Captured on a Remidio Fundus on Phone — 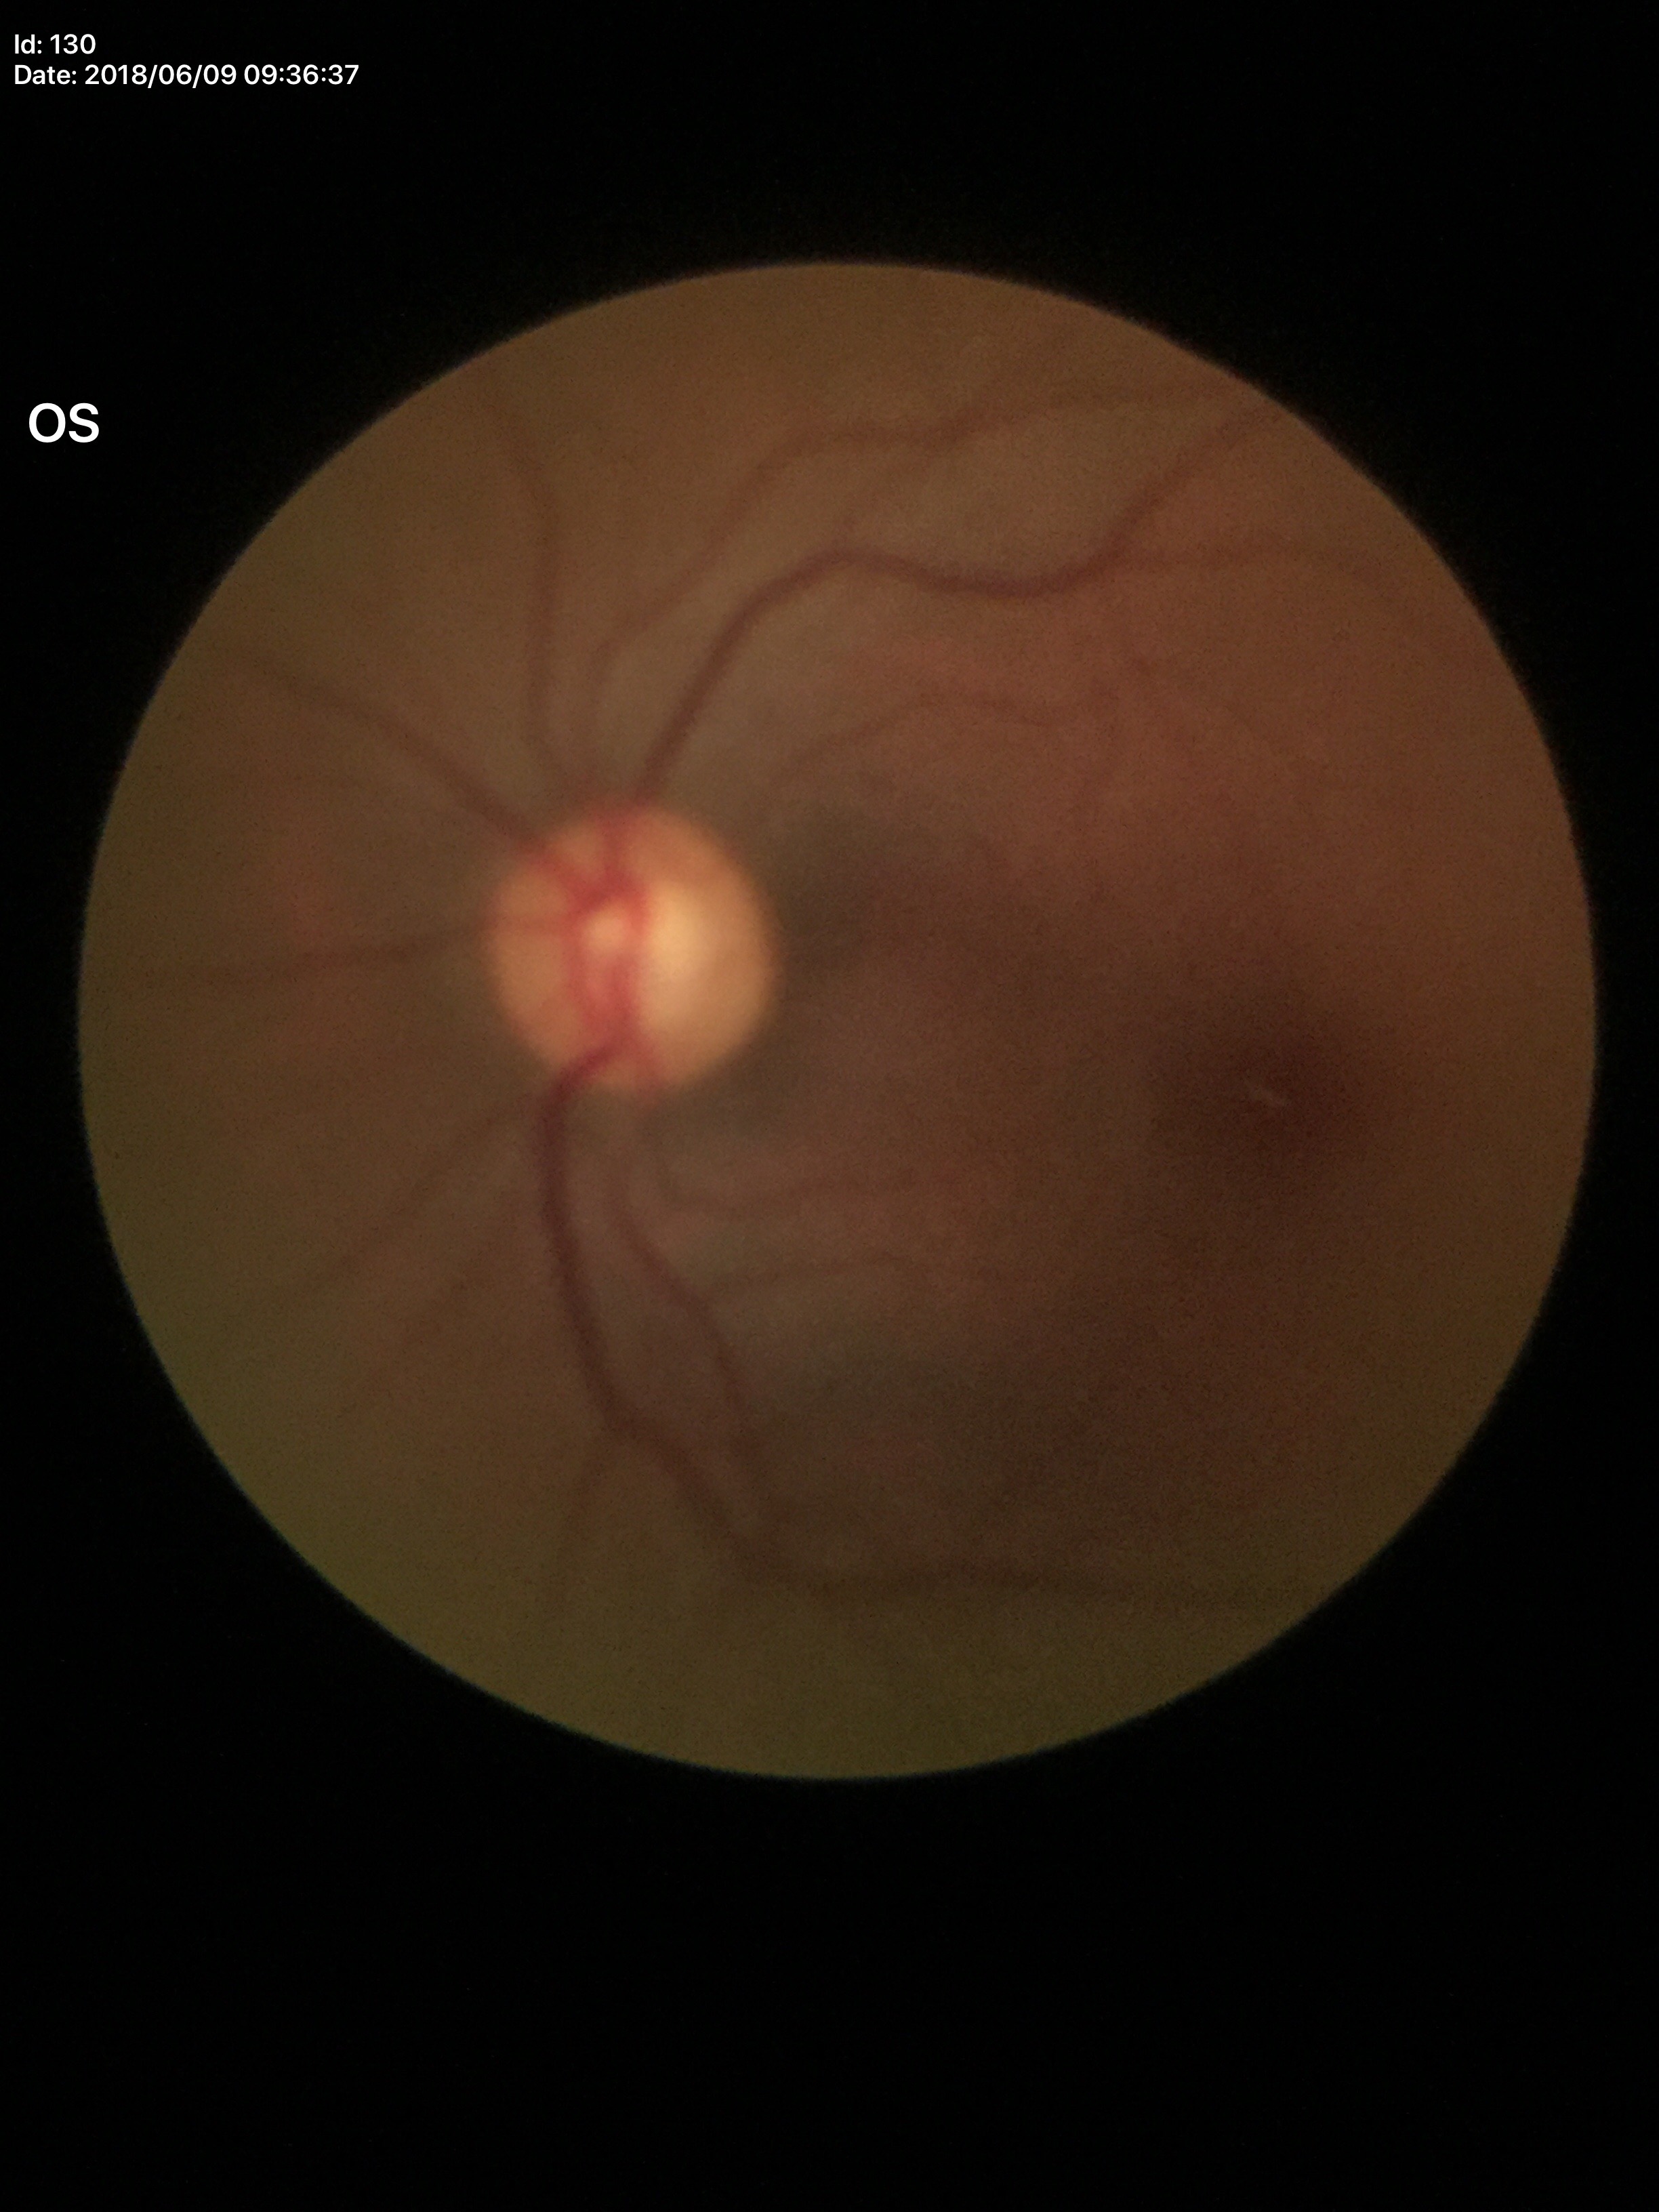
Annotations:
– vertical CDR (VCDR) · 0.58
– horizontal C/D ratio (HCDR) · 0.53
– Glaucoma impression · not suspect (1/5 graders called glaucoma suspect)
– area cup-disc ratio (ACDR) · 0.30